45° FOV; modified Davis classification; NIDEK AFC-230 fundus camera: 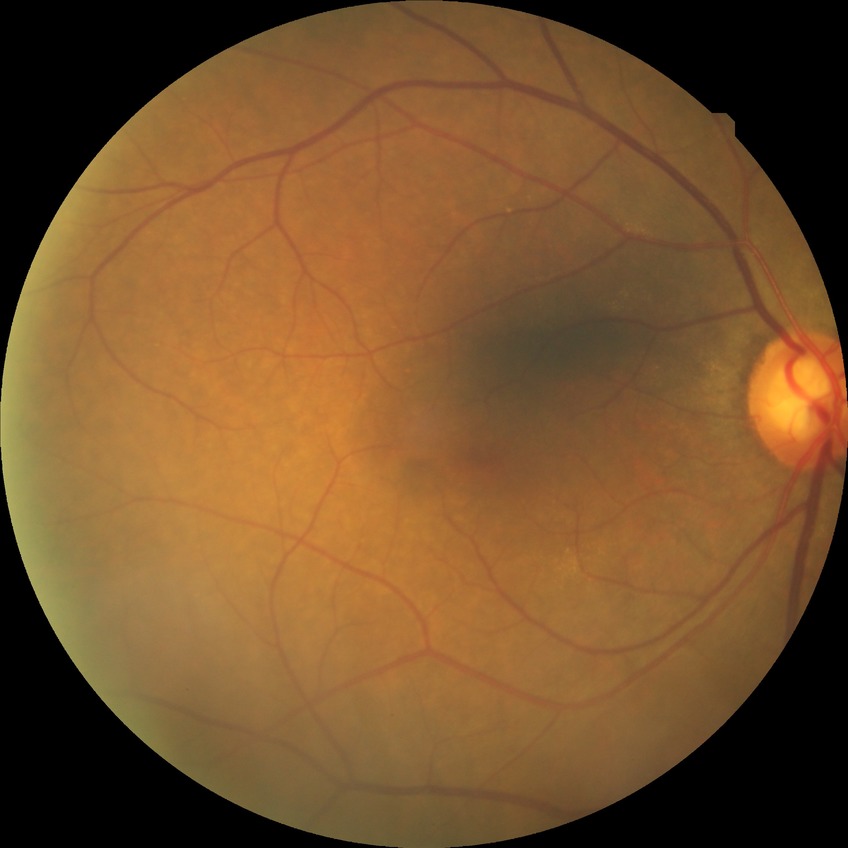 Modified Davis classification is no diabetic retinopathy.